Image size 848x848; 45 degree fundus photograph; color fundus photograph: 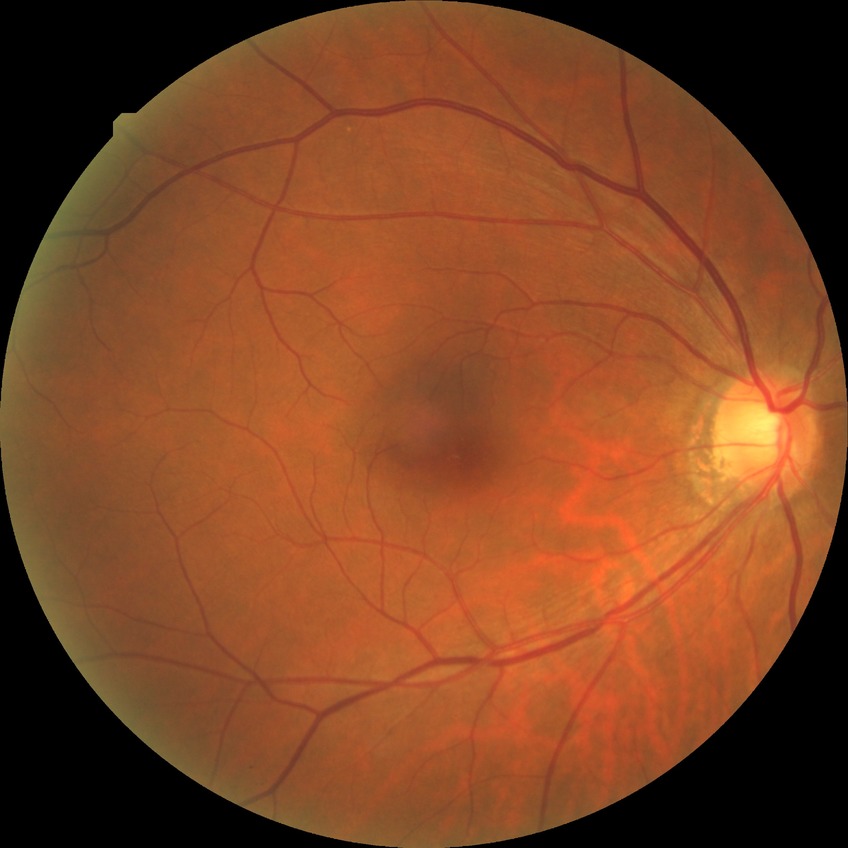

DR severity is NDR.